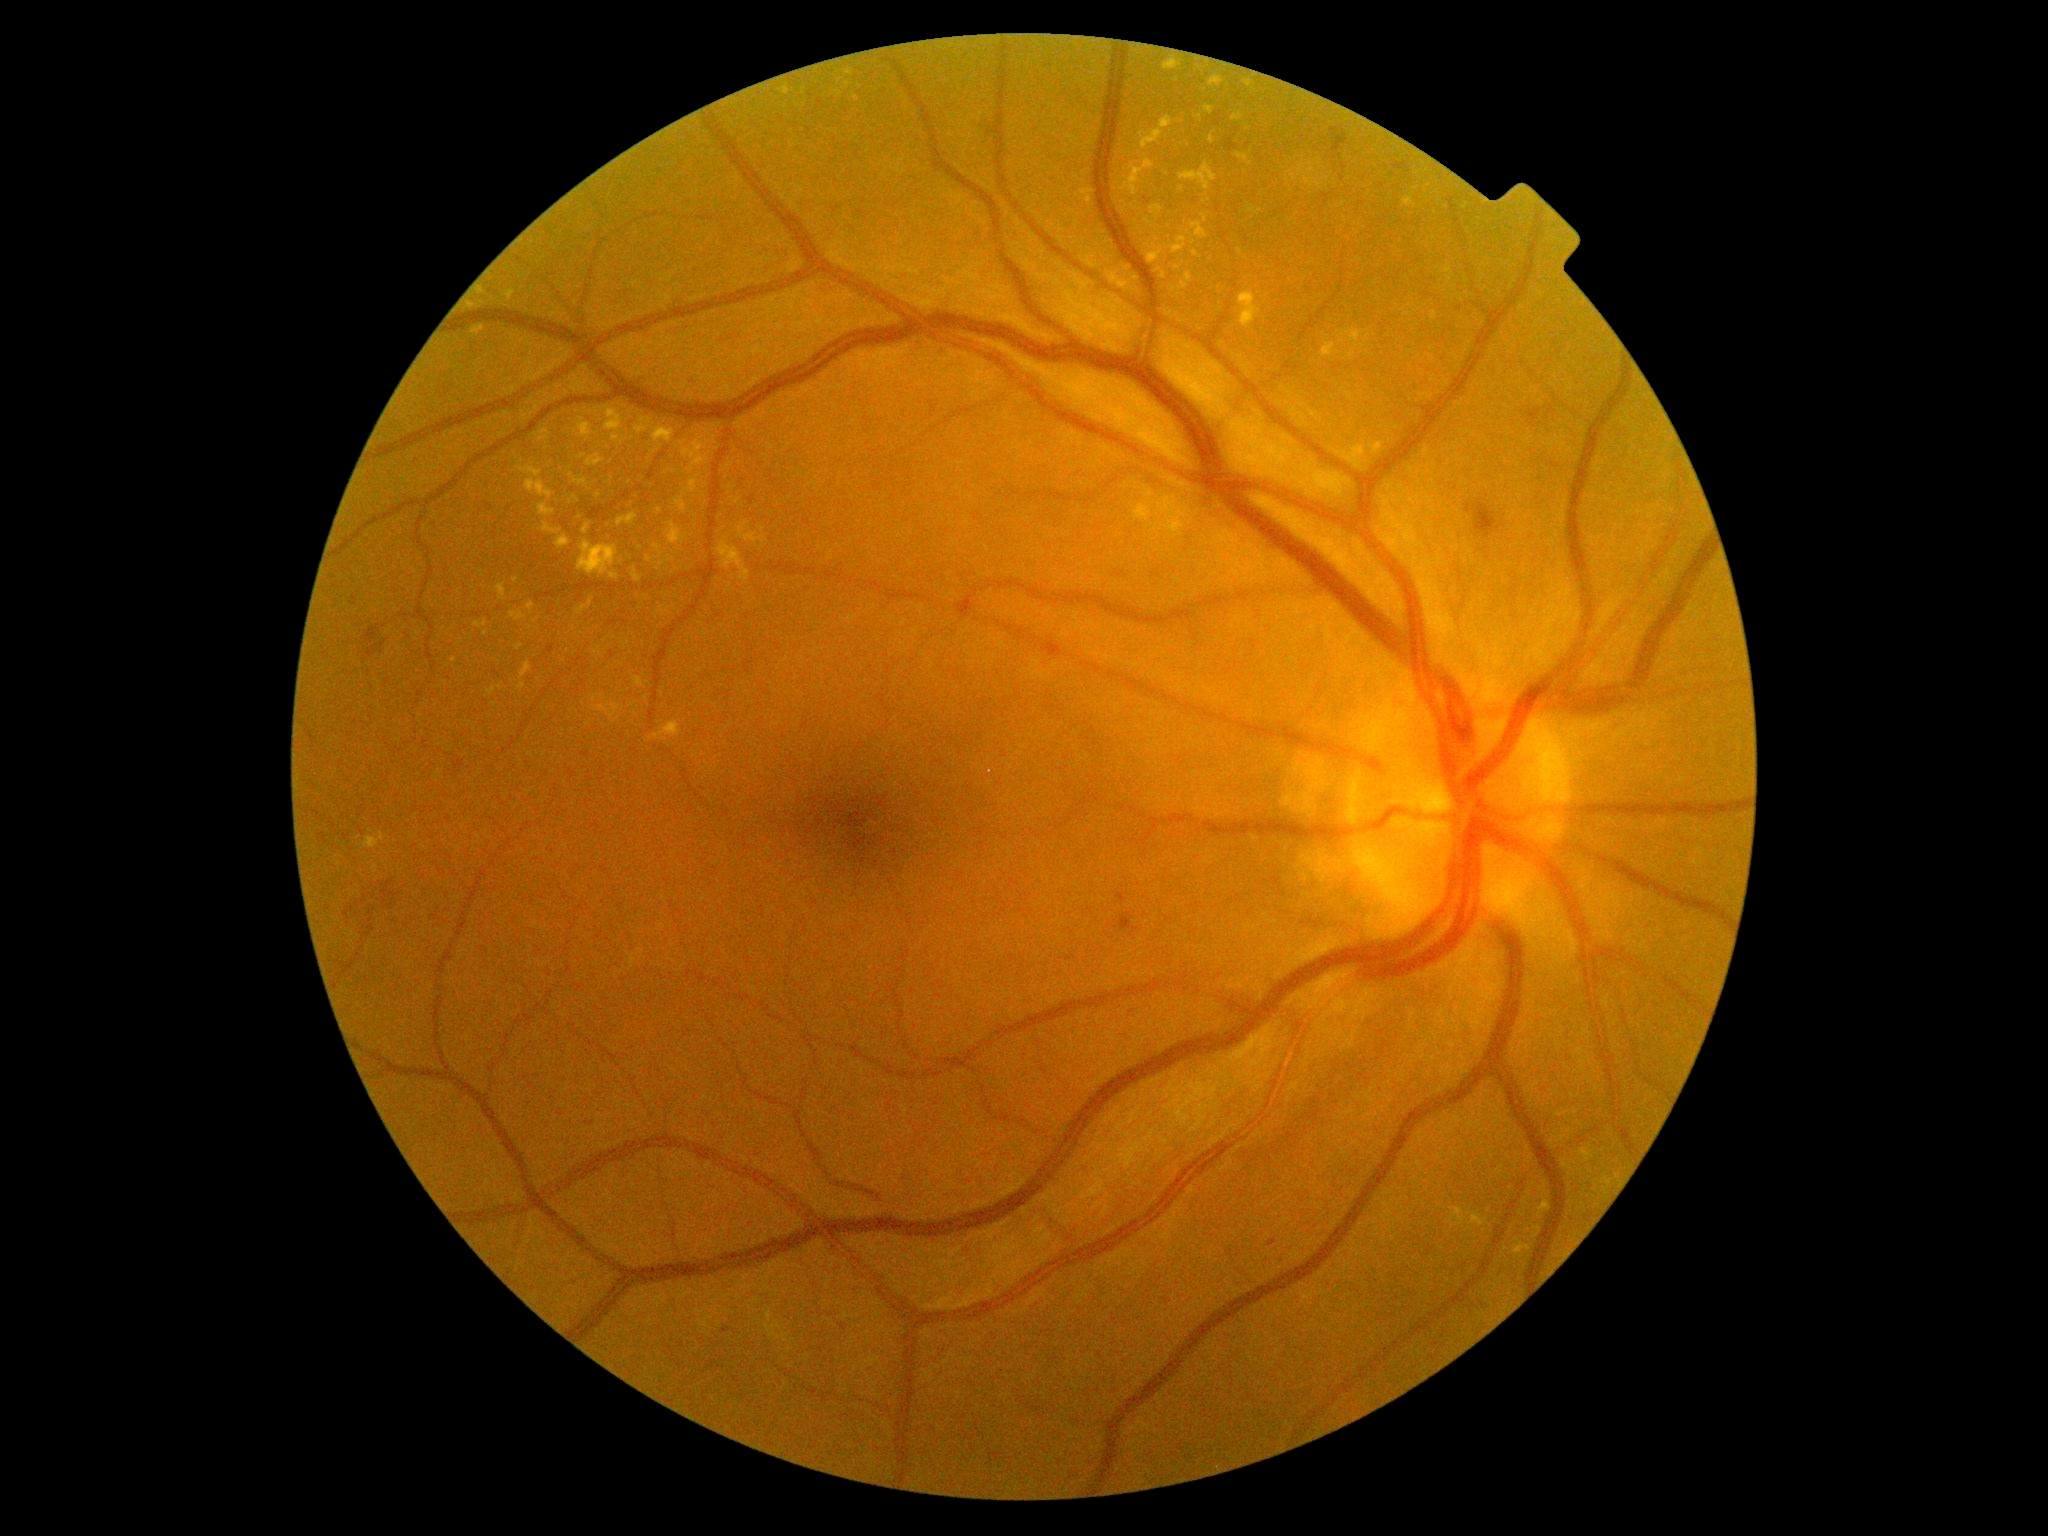

Diabetic retinopathy is grade 2 — more than just microaneurysms but less than severe NPDR
A subset of detected lesions:
soft exudates = absent
microaneurysms = x1=1120, y1=914, x2=1133, y2=932 | x1=987, y1=128, x2=993, y2=136 | x1=582, y1=753, x2=591, y2=759 | x1=548, y1=646, x2=555, y2=654 | x1=1117, y1=894, x2=1126, y2=902 | x1=1269, y1=1241, x2=1277, y2=1247 | x1=1226, y1=139, x2=1238, y2=151 | x1=611, y1=651, x2=614, y2=659
Small microaneurysms near 752:501 | 1147:201
hard exudates (more not shown) = x1=1236, y1=153, x2=1249, y2=162 | x1=657, y1=562, x2=667, y2=567 | x1=1515, y1=1238, x2=1532, y2=1260 | x1=594, y1=647, x2=602, y2=656 | x1=635, y1=426, x2=650, y2=435 | x1=676, y1=475, x2=703, y2=514 | x1=1135, y1=486, x2=1192, y2=539 | x1=1472, y1=1214, x2=1489, y2=1228 | x1=569, y1=473, x2=589, y2=489 | x1=539, y1=504, x2=555, y2=516 | x1=1305, y1=179, x2=1315, y2=188 | x1=592, y1=703, x2=621, y2=724 | x1=579, y1=455, x2=587, y2=459
Small hard exudates near 662:447 | 630:483 | 580:517 | 622:561 | 1139:229 | 856:98 | 1170:226
hemorrhages = x1=1528, y1=409, x2=1542, y2=426 | x1=347, y1=879, x2=396, y2=927 | x1=381, y1=640, x2=389, y2=647 | x1=455, y1=760, x2=465, y2=770 | x1=1331, y1=128, x2=1348, y2=153 | x1=351, y1=597, x2=358, y2=607 | x1=366, y1=627, x2=381, y2=644 | x1=367, y1=646, x2=378, y2=659 | x1=1466, y1=502, x2=1497, y2=539